Wide-field contact fundus photograph of an infant:
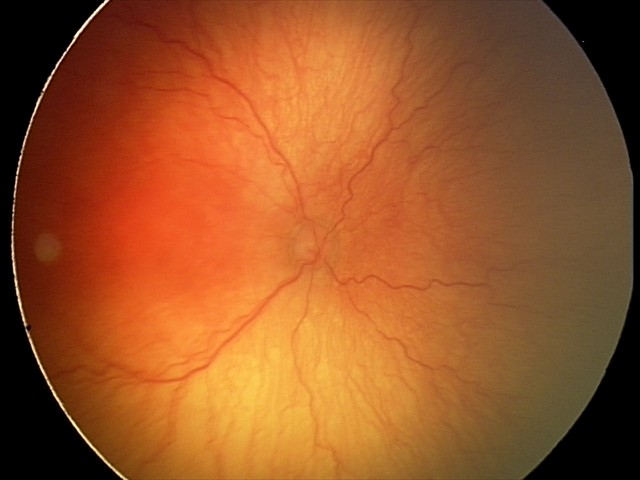
Assessment = A-ROP (aggressive ROP)
plus disease = present